45° field of view — 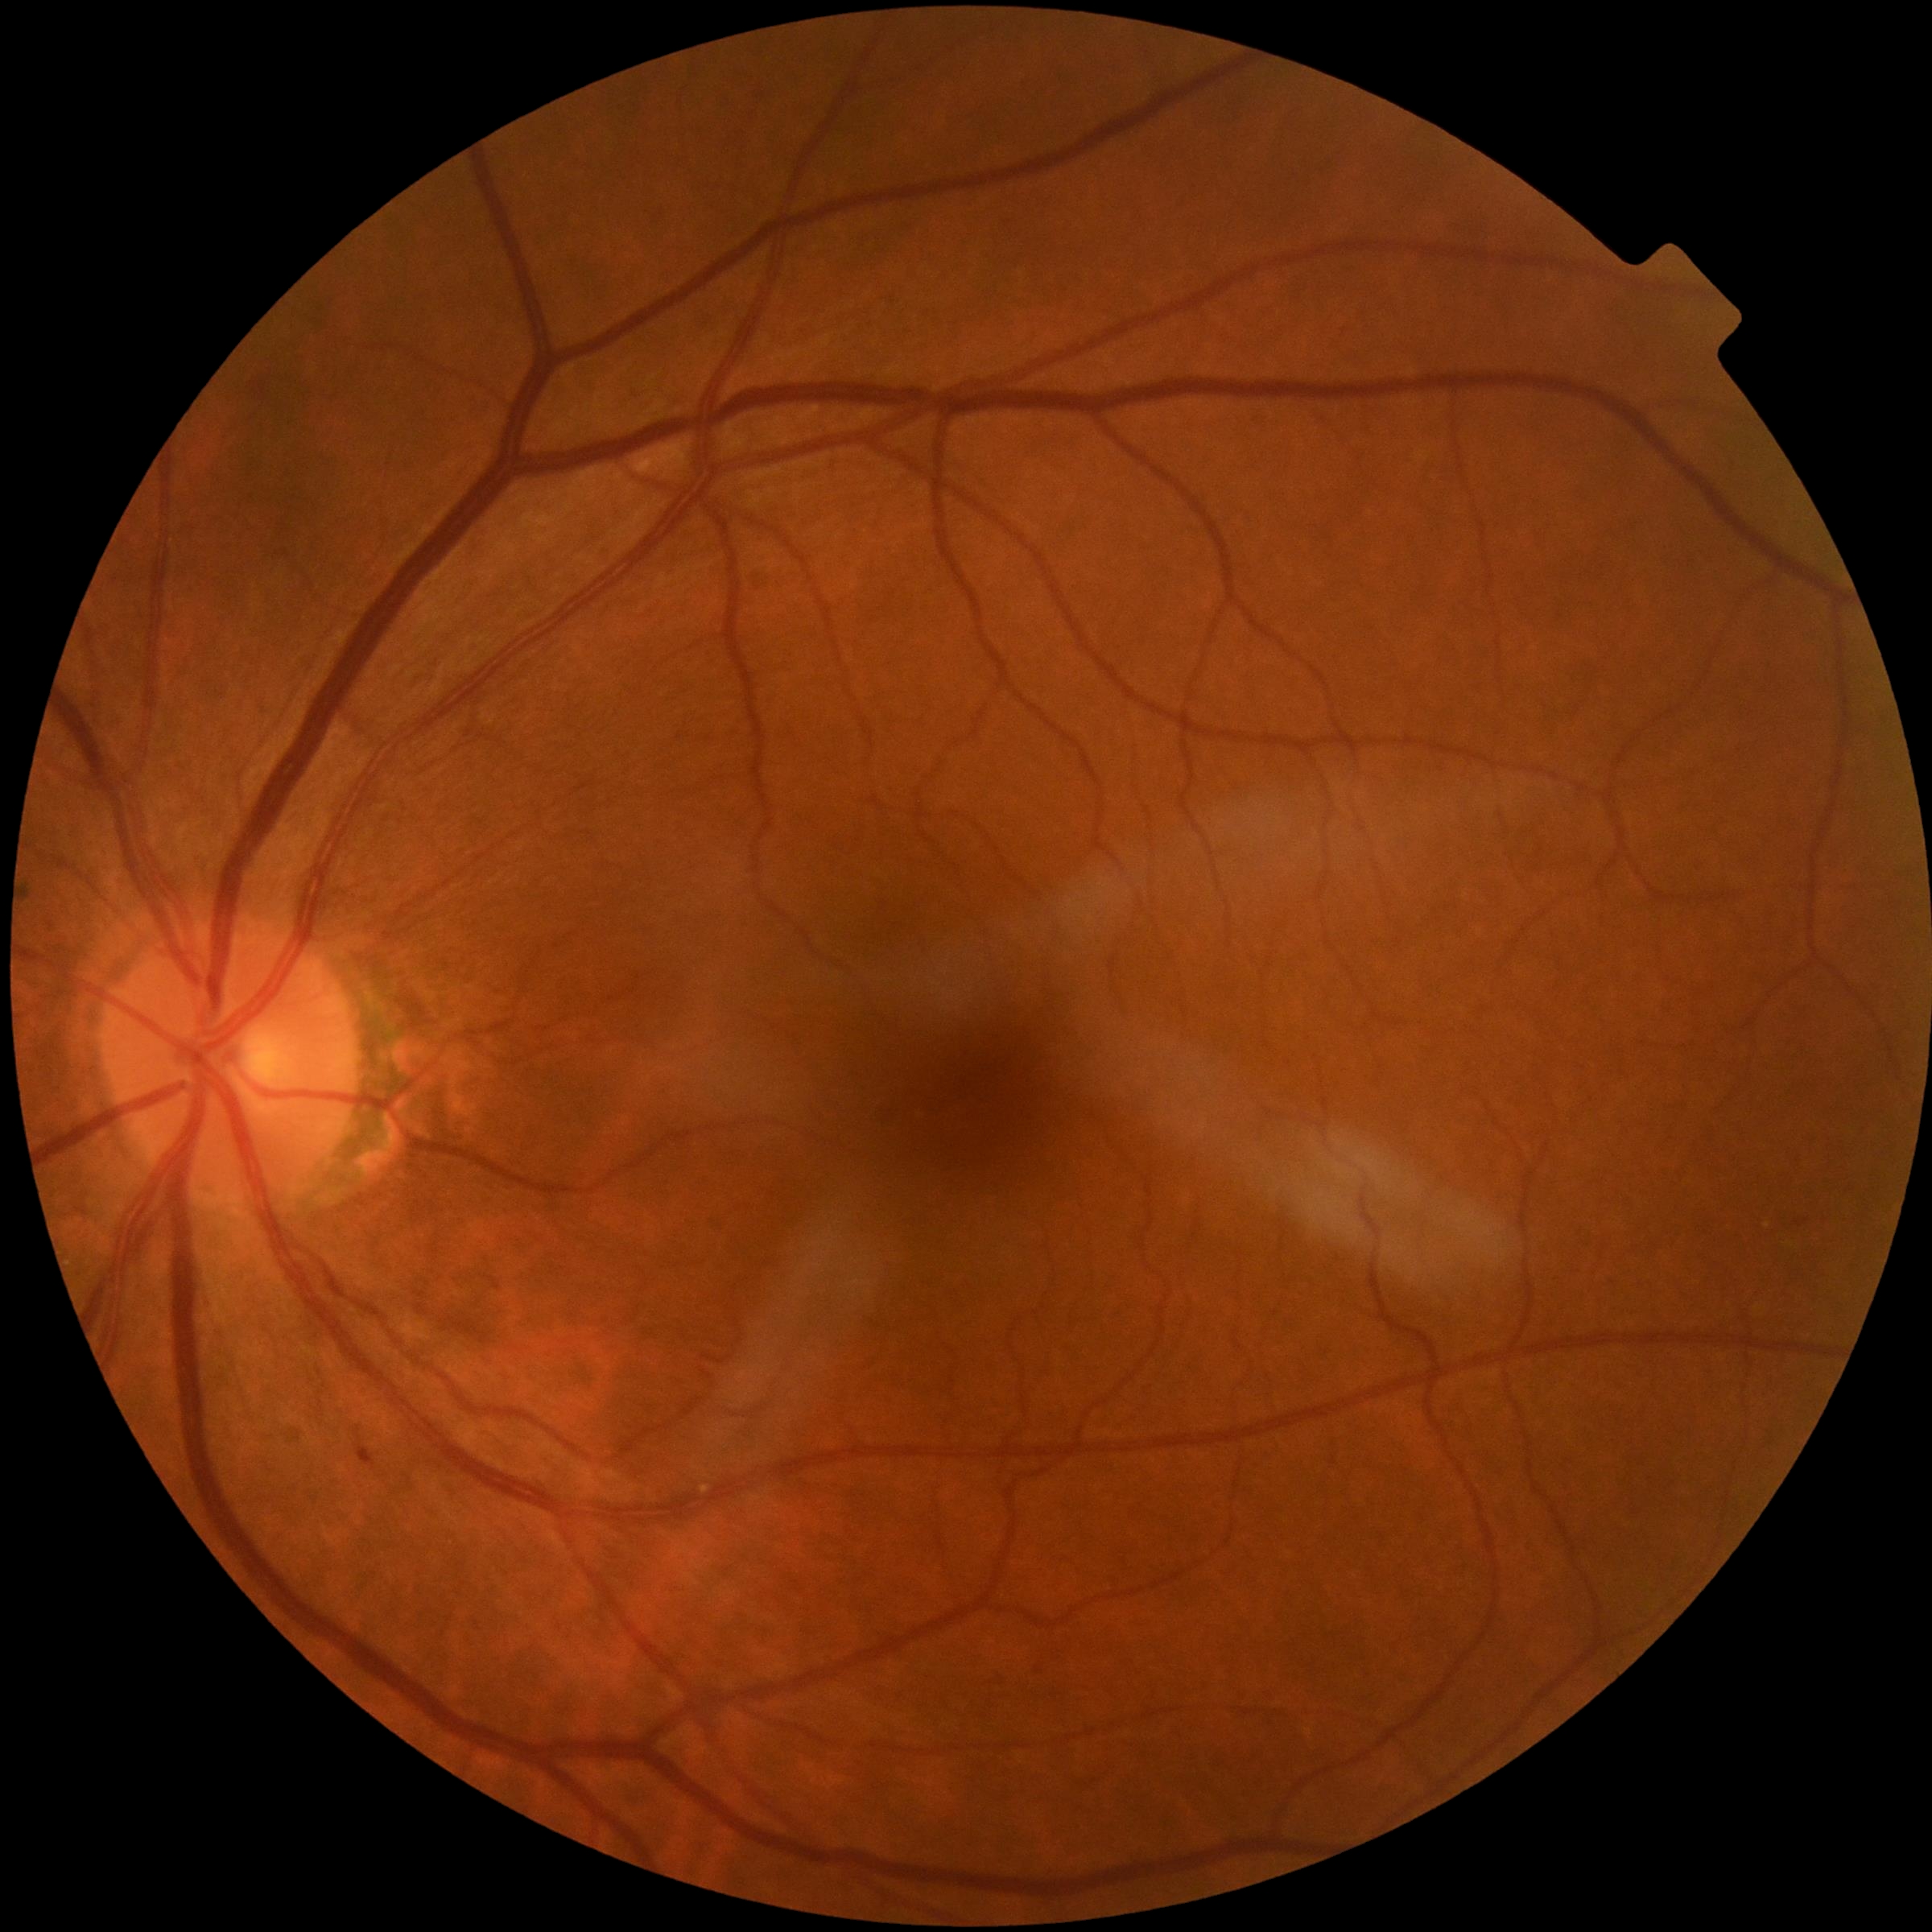

diabetic retinopathy@1 — presence of microaneurysms only.